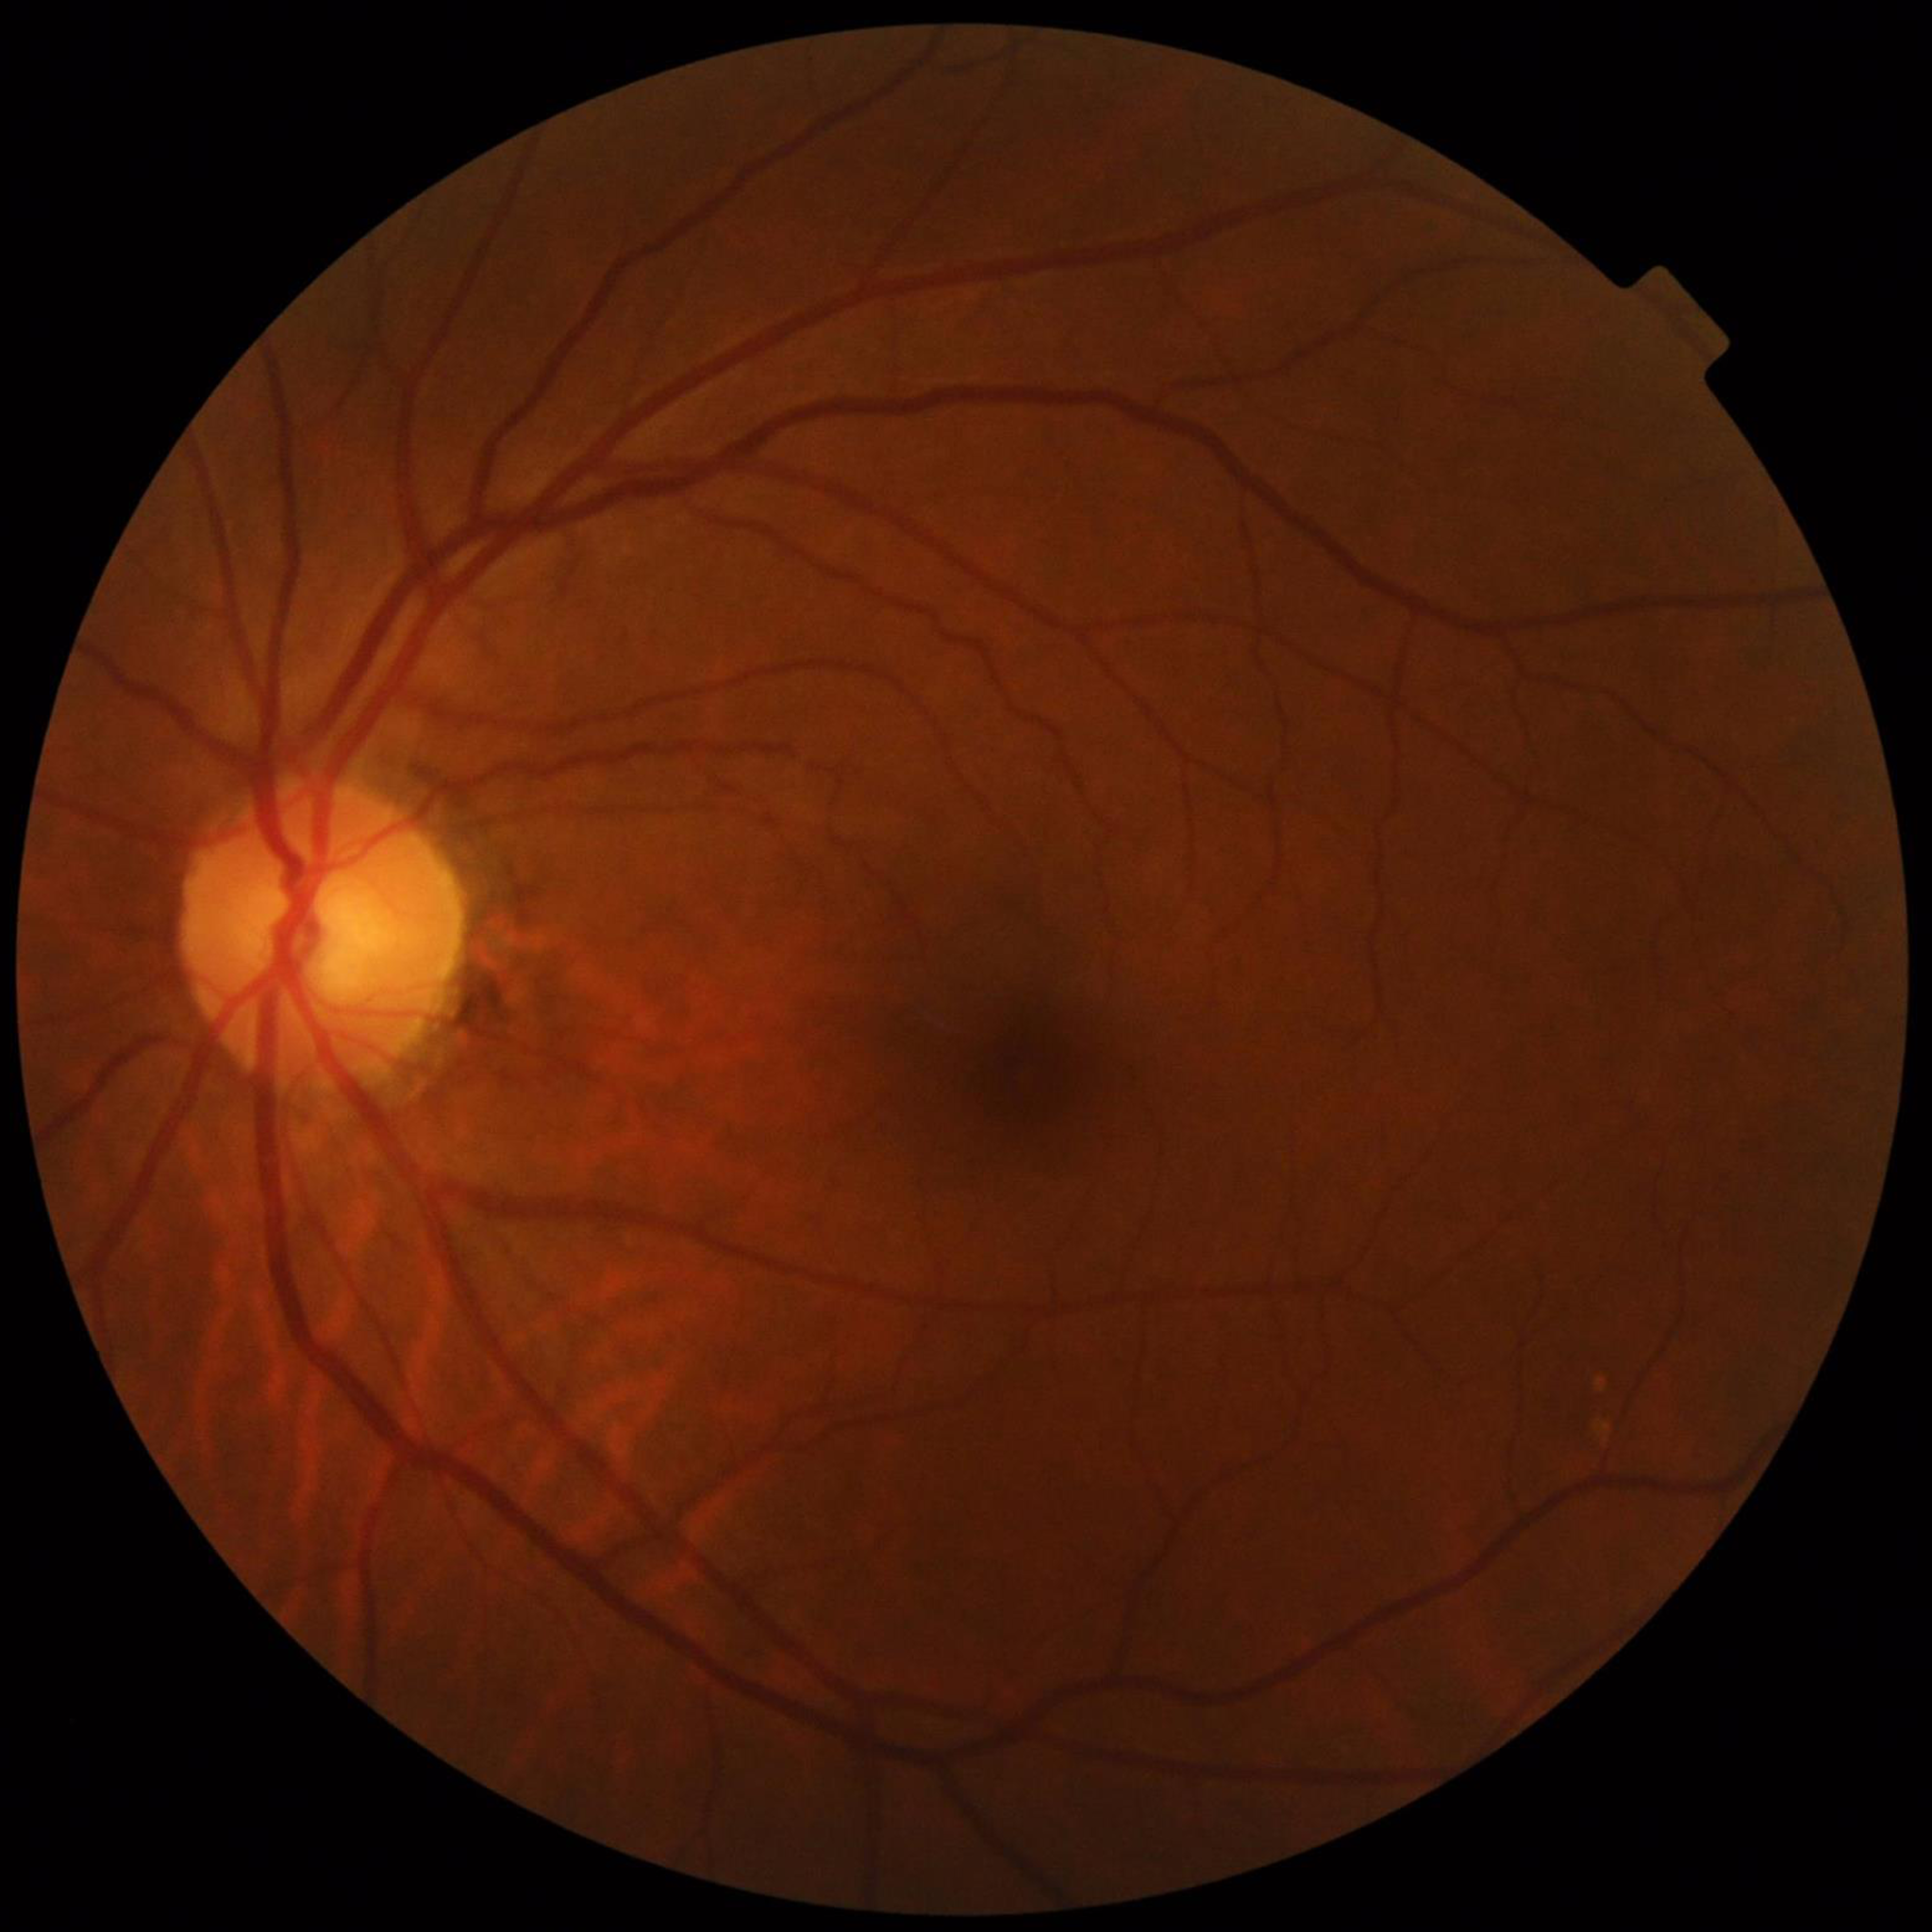 Disease class: diabetic retinopathy (DR)